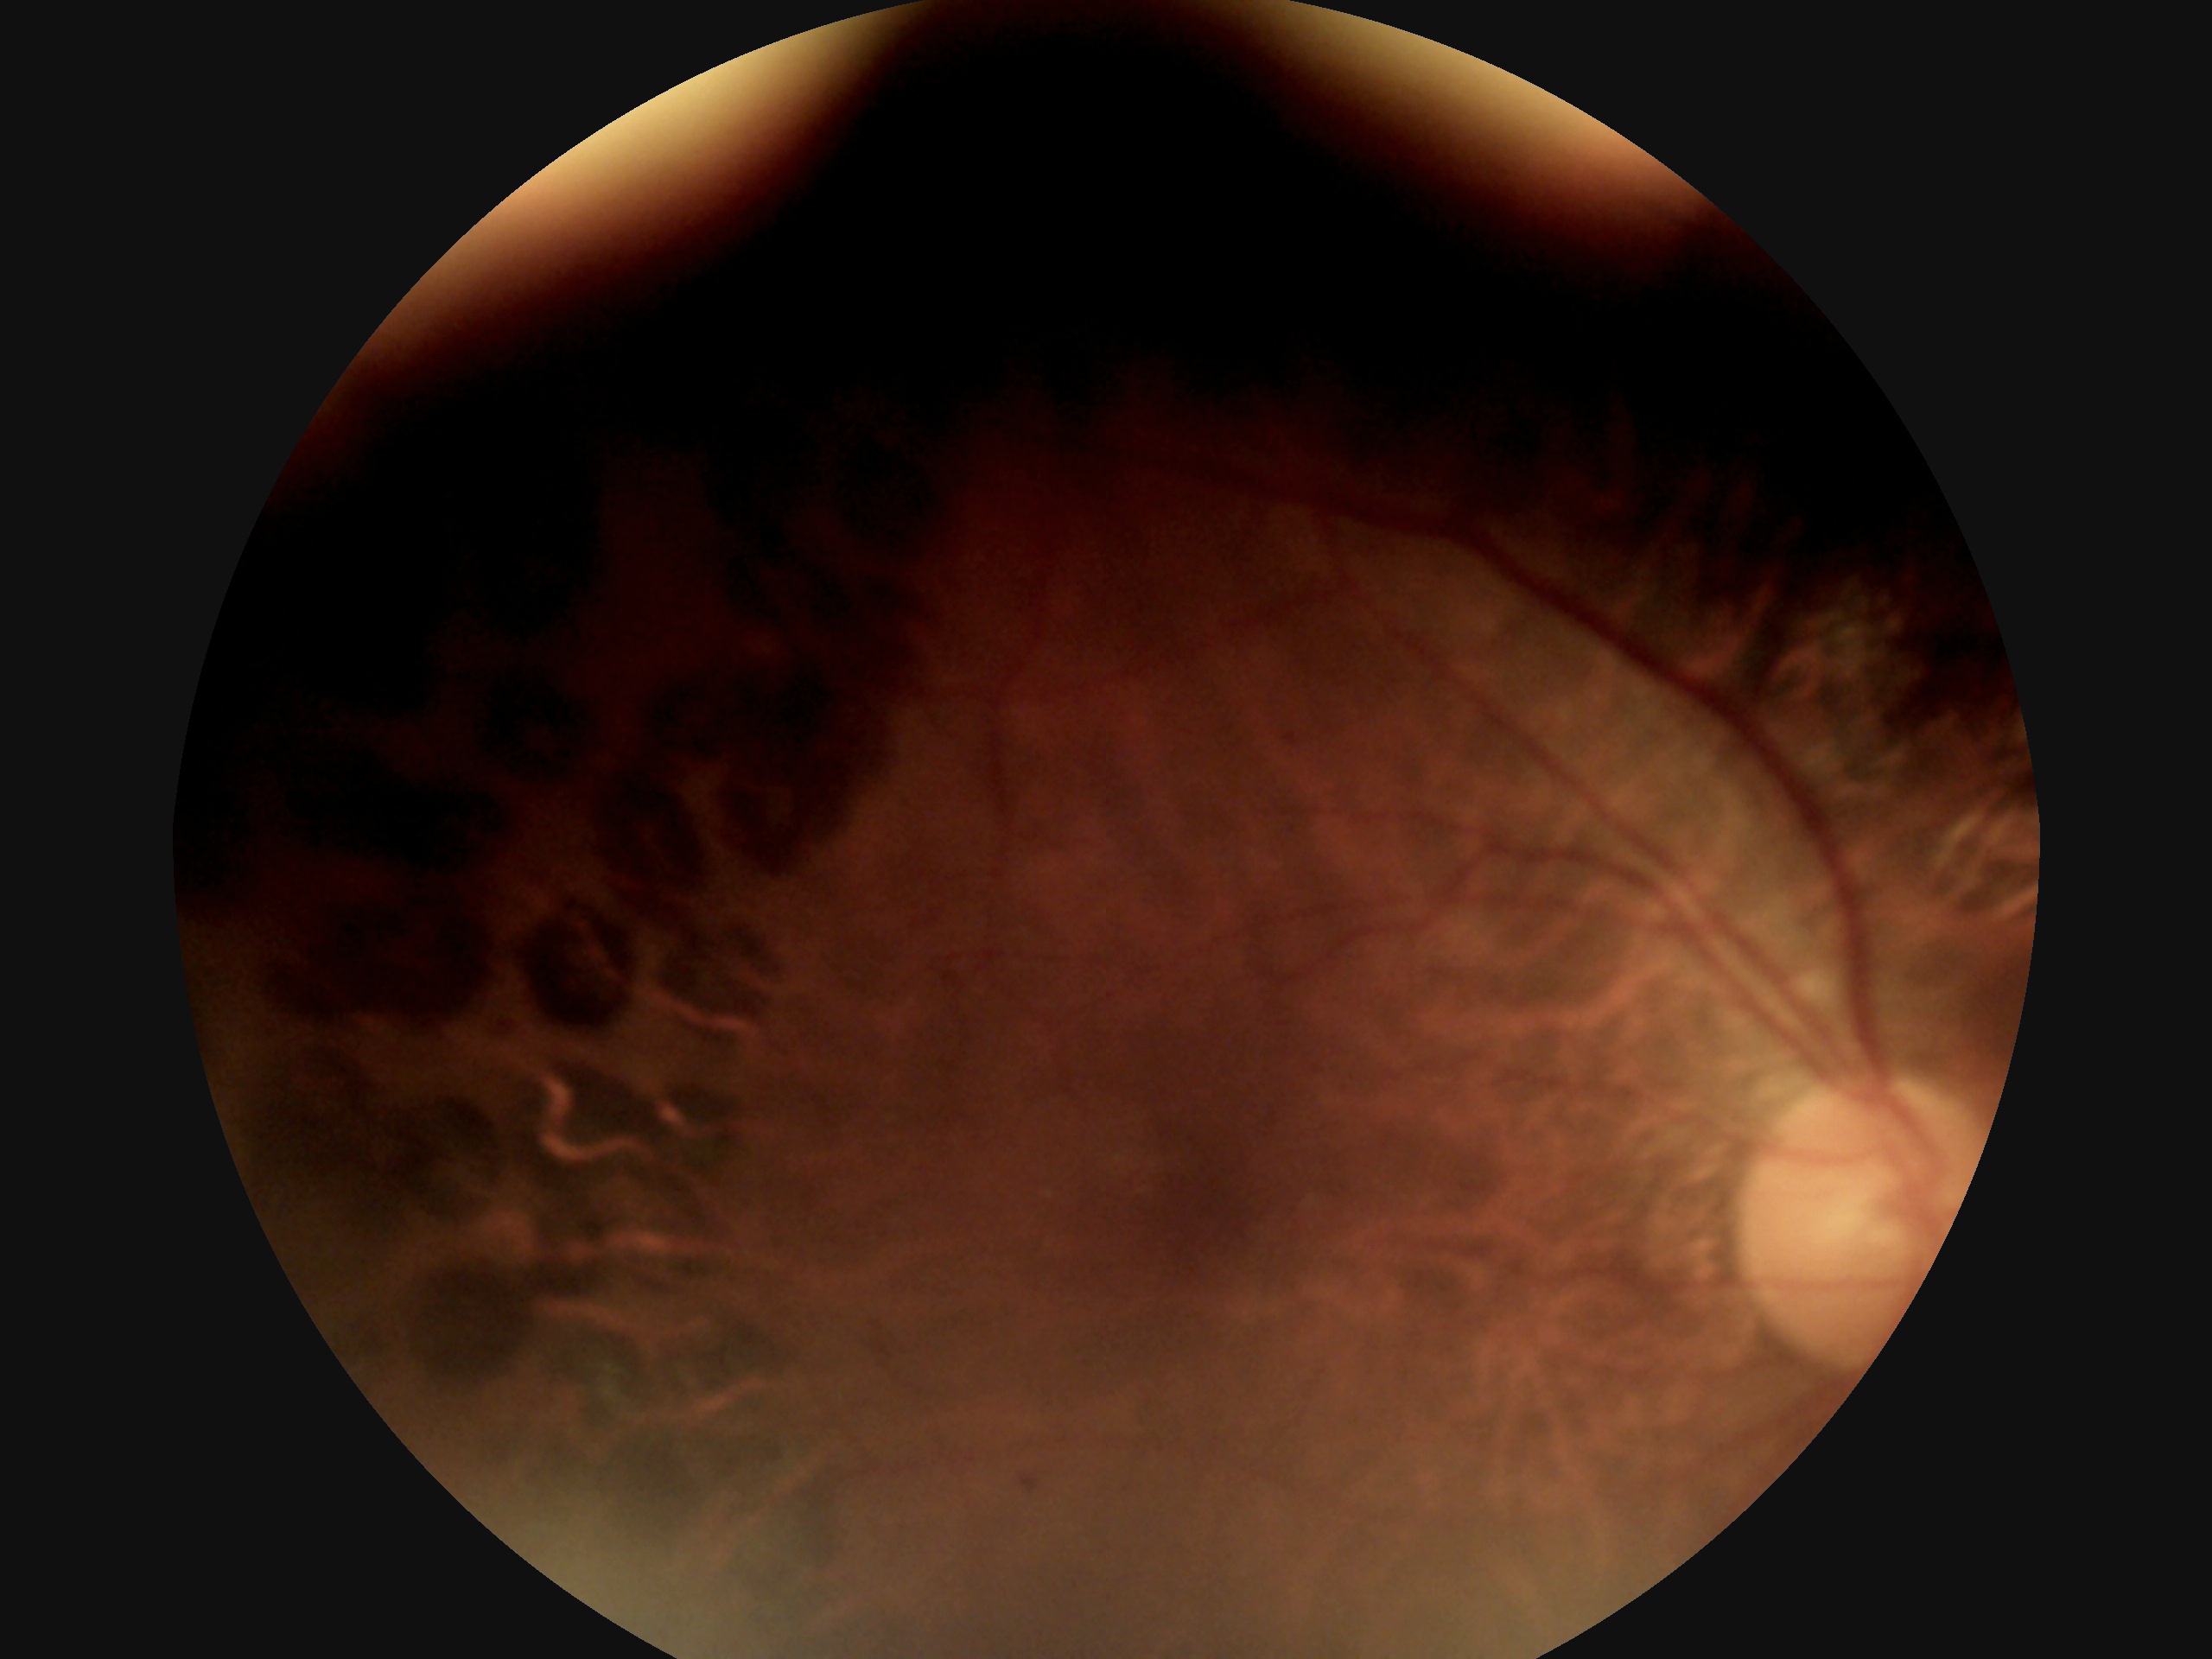 DR class = non-proliferative diabetic retinopathy; DR = 1/4.